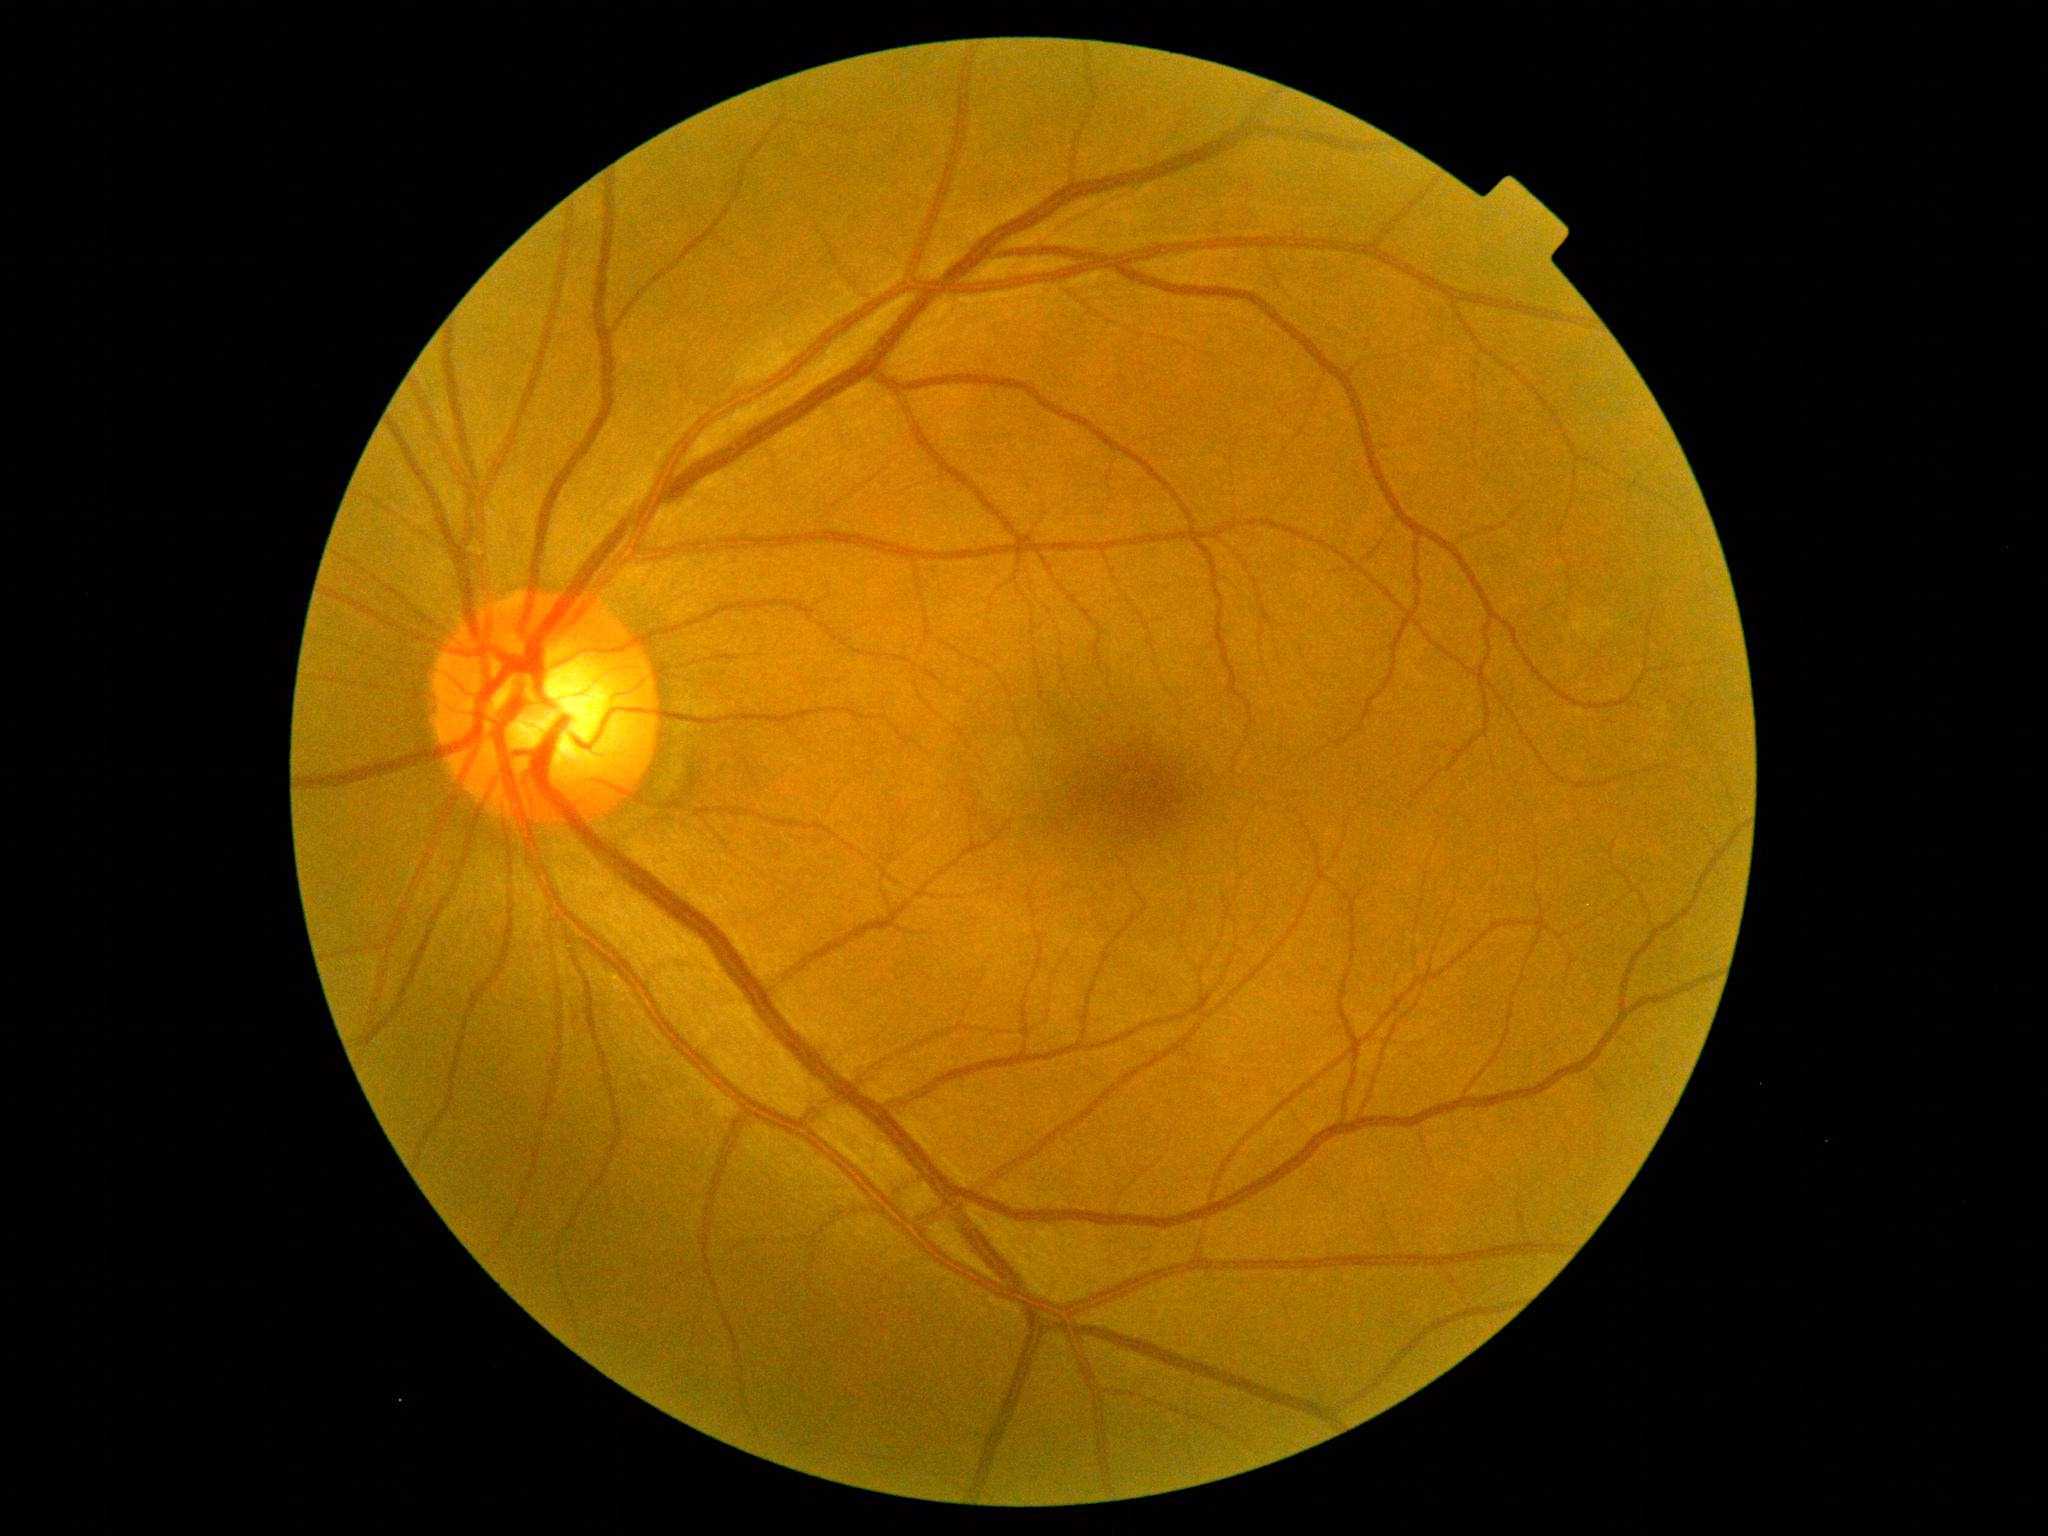
Diabetic retinopathy is grade 0.